2089x1764
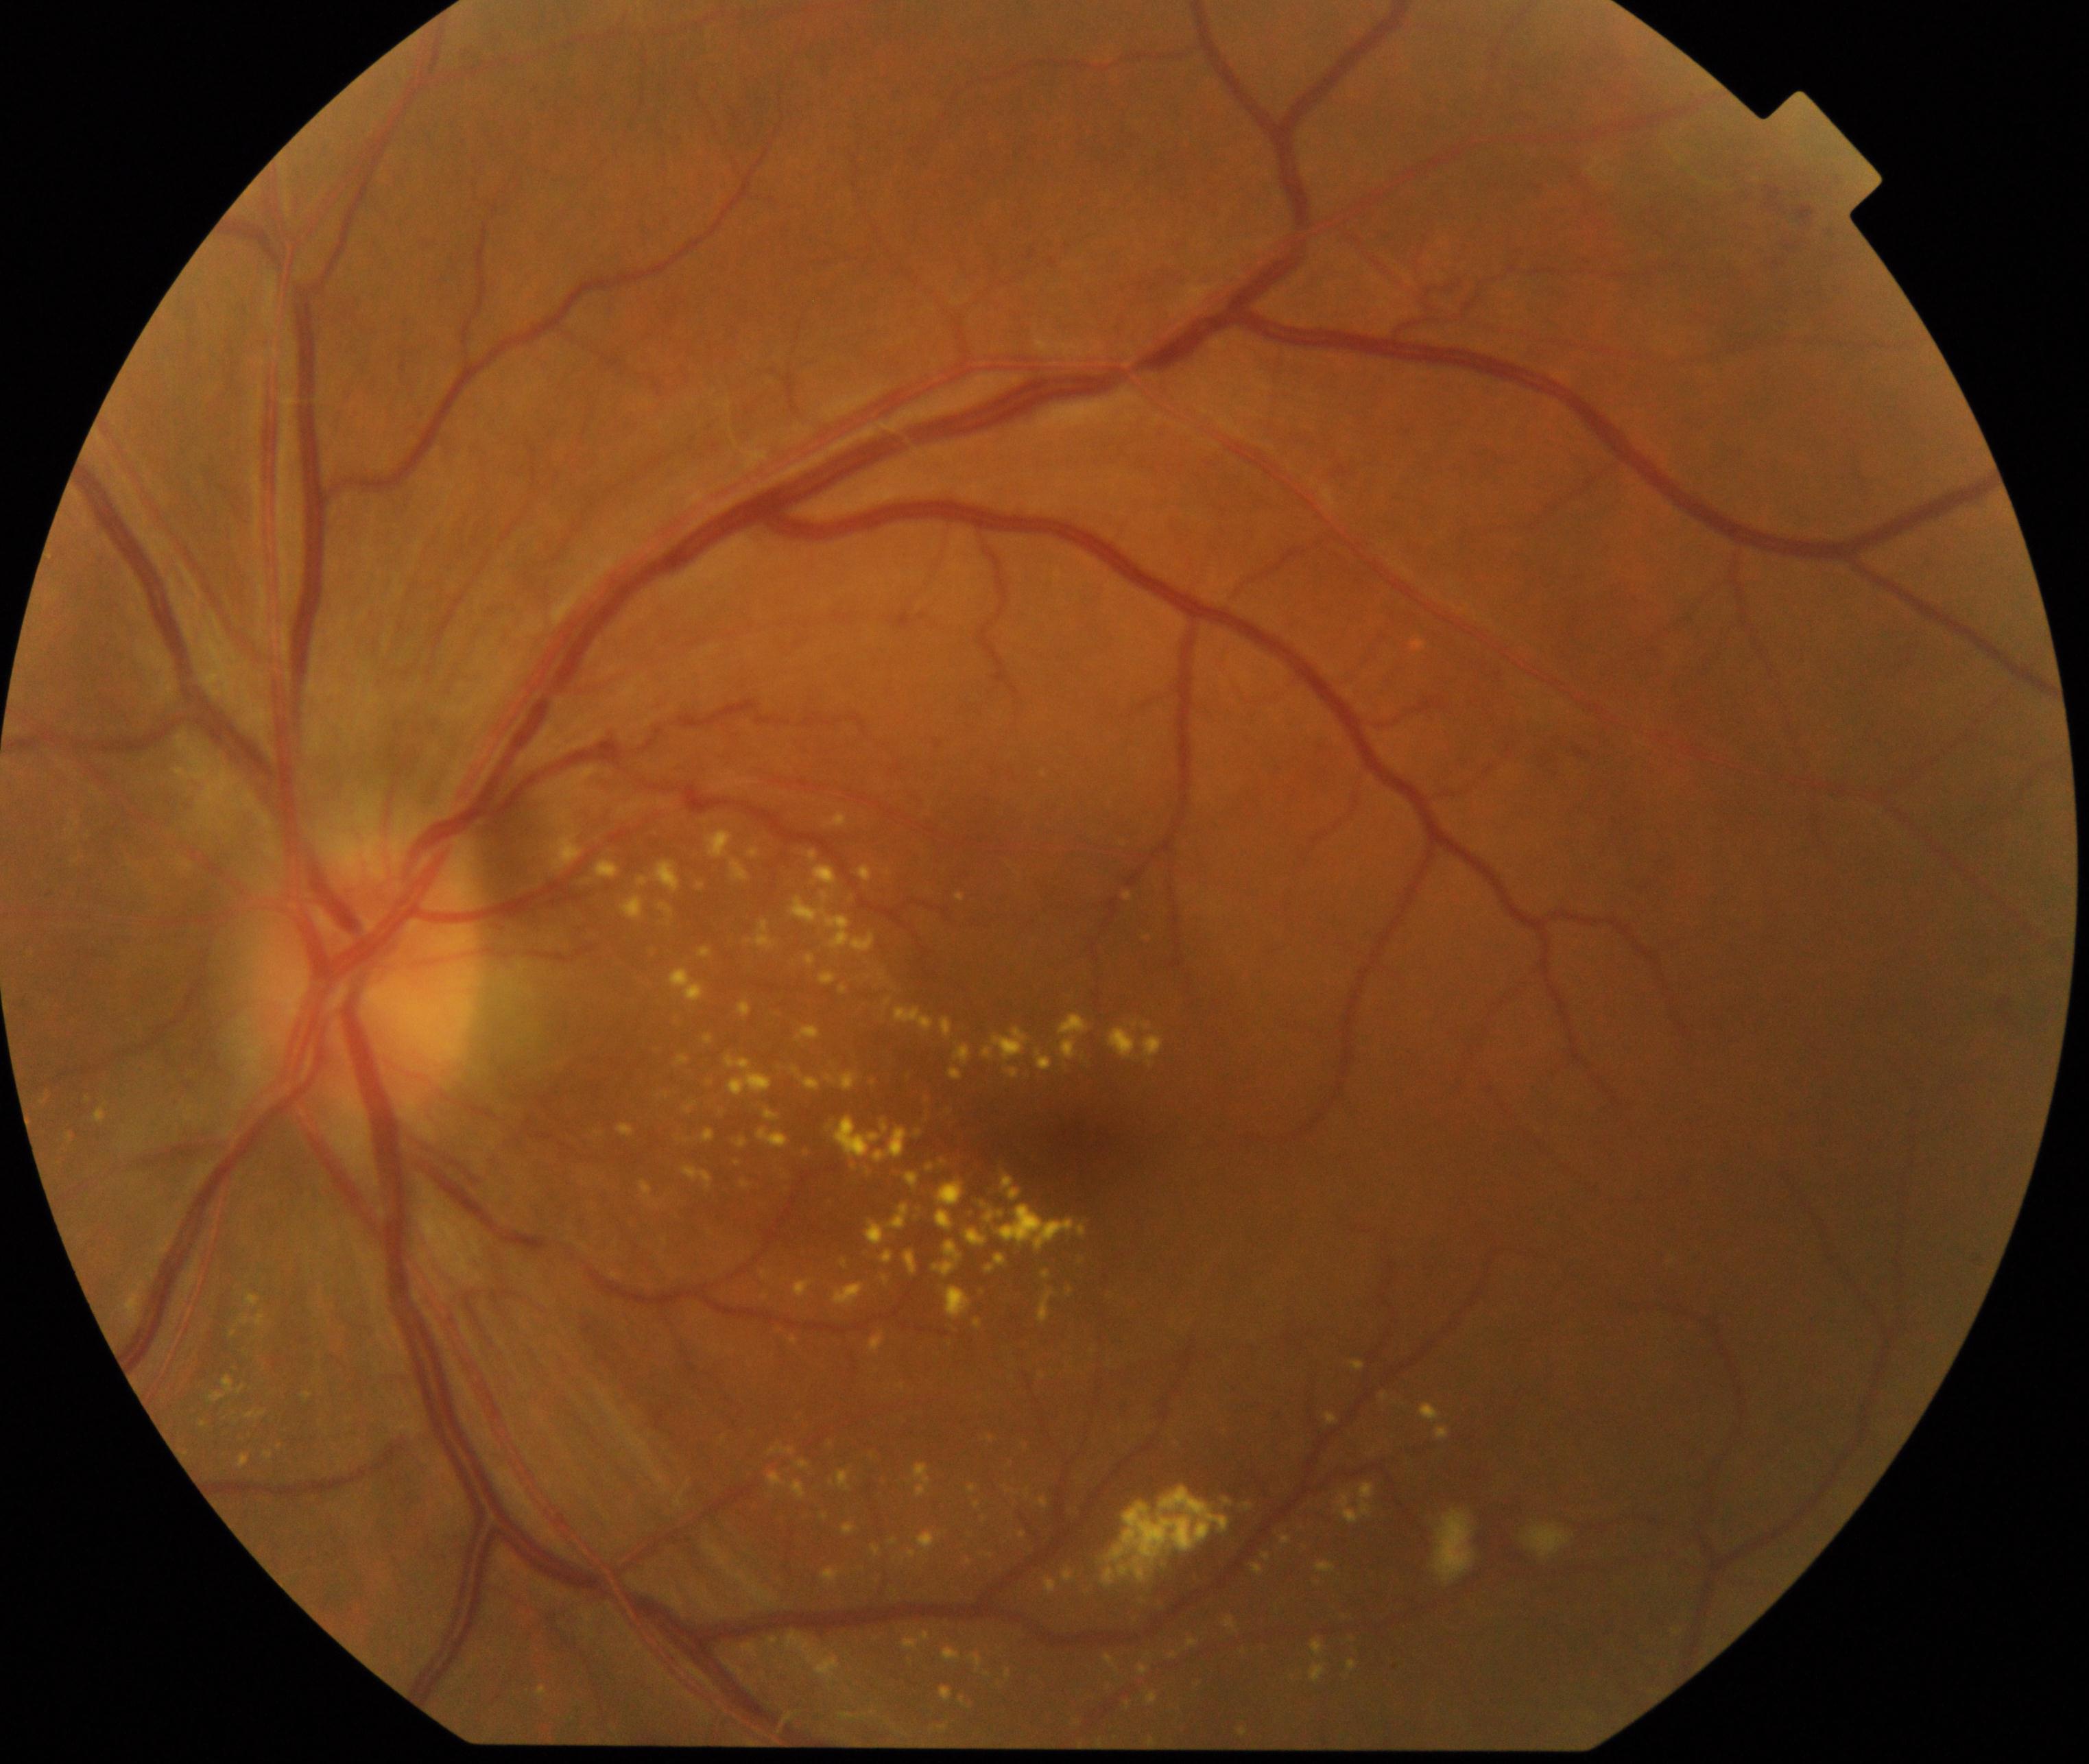
Findings: moderate non-proliferative diabetic retinopathy.